FOV: 45 degrees, 1444 by 1444 pixels.
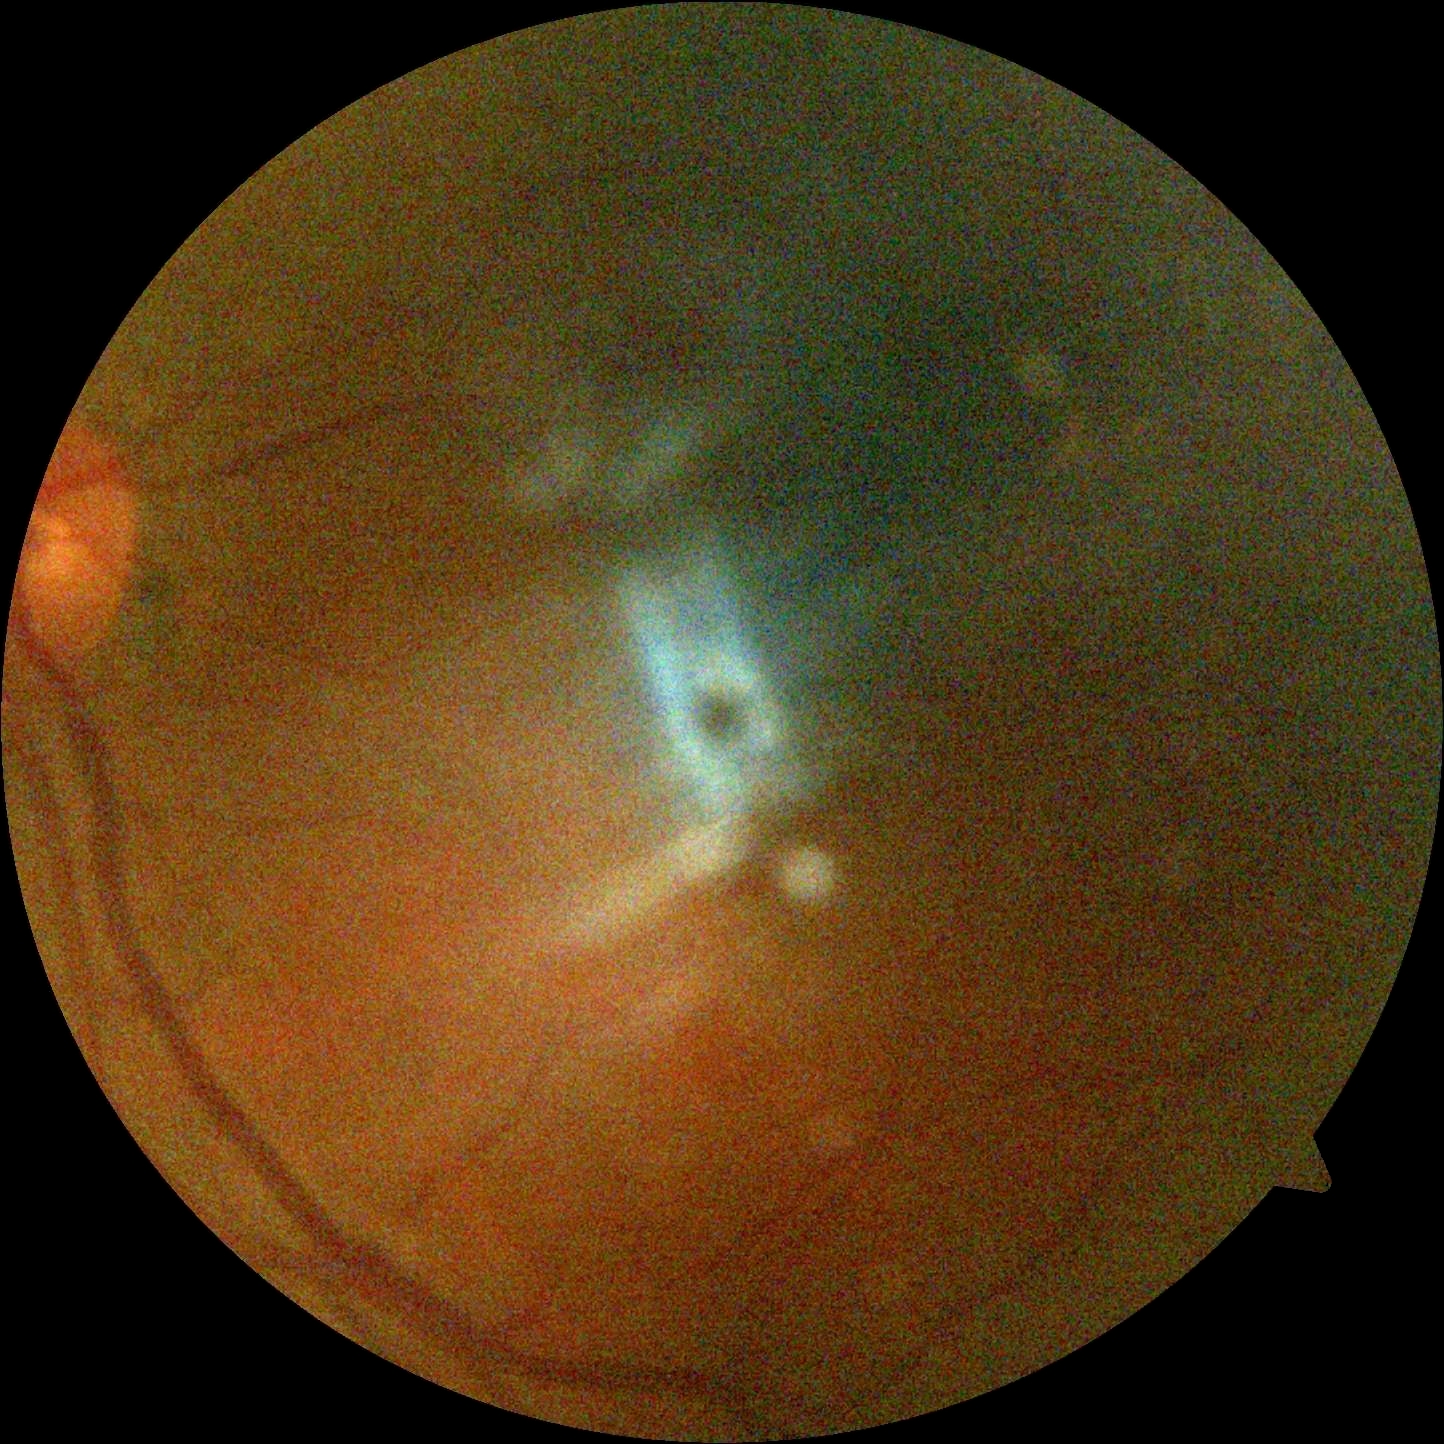 image quality@too poor for DR grading; diabetic retinopathy (DR)@ungradable due to poor image quality.